Dilated-pupil acquisition. Acquired with a Topcon TRC-50DX.
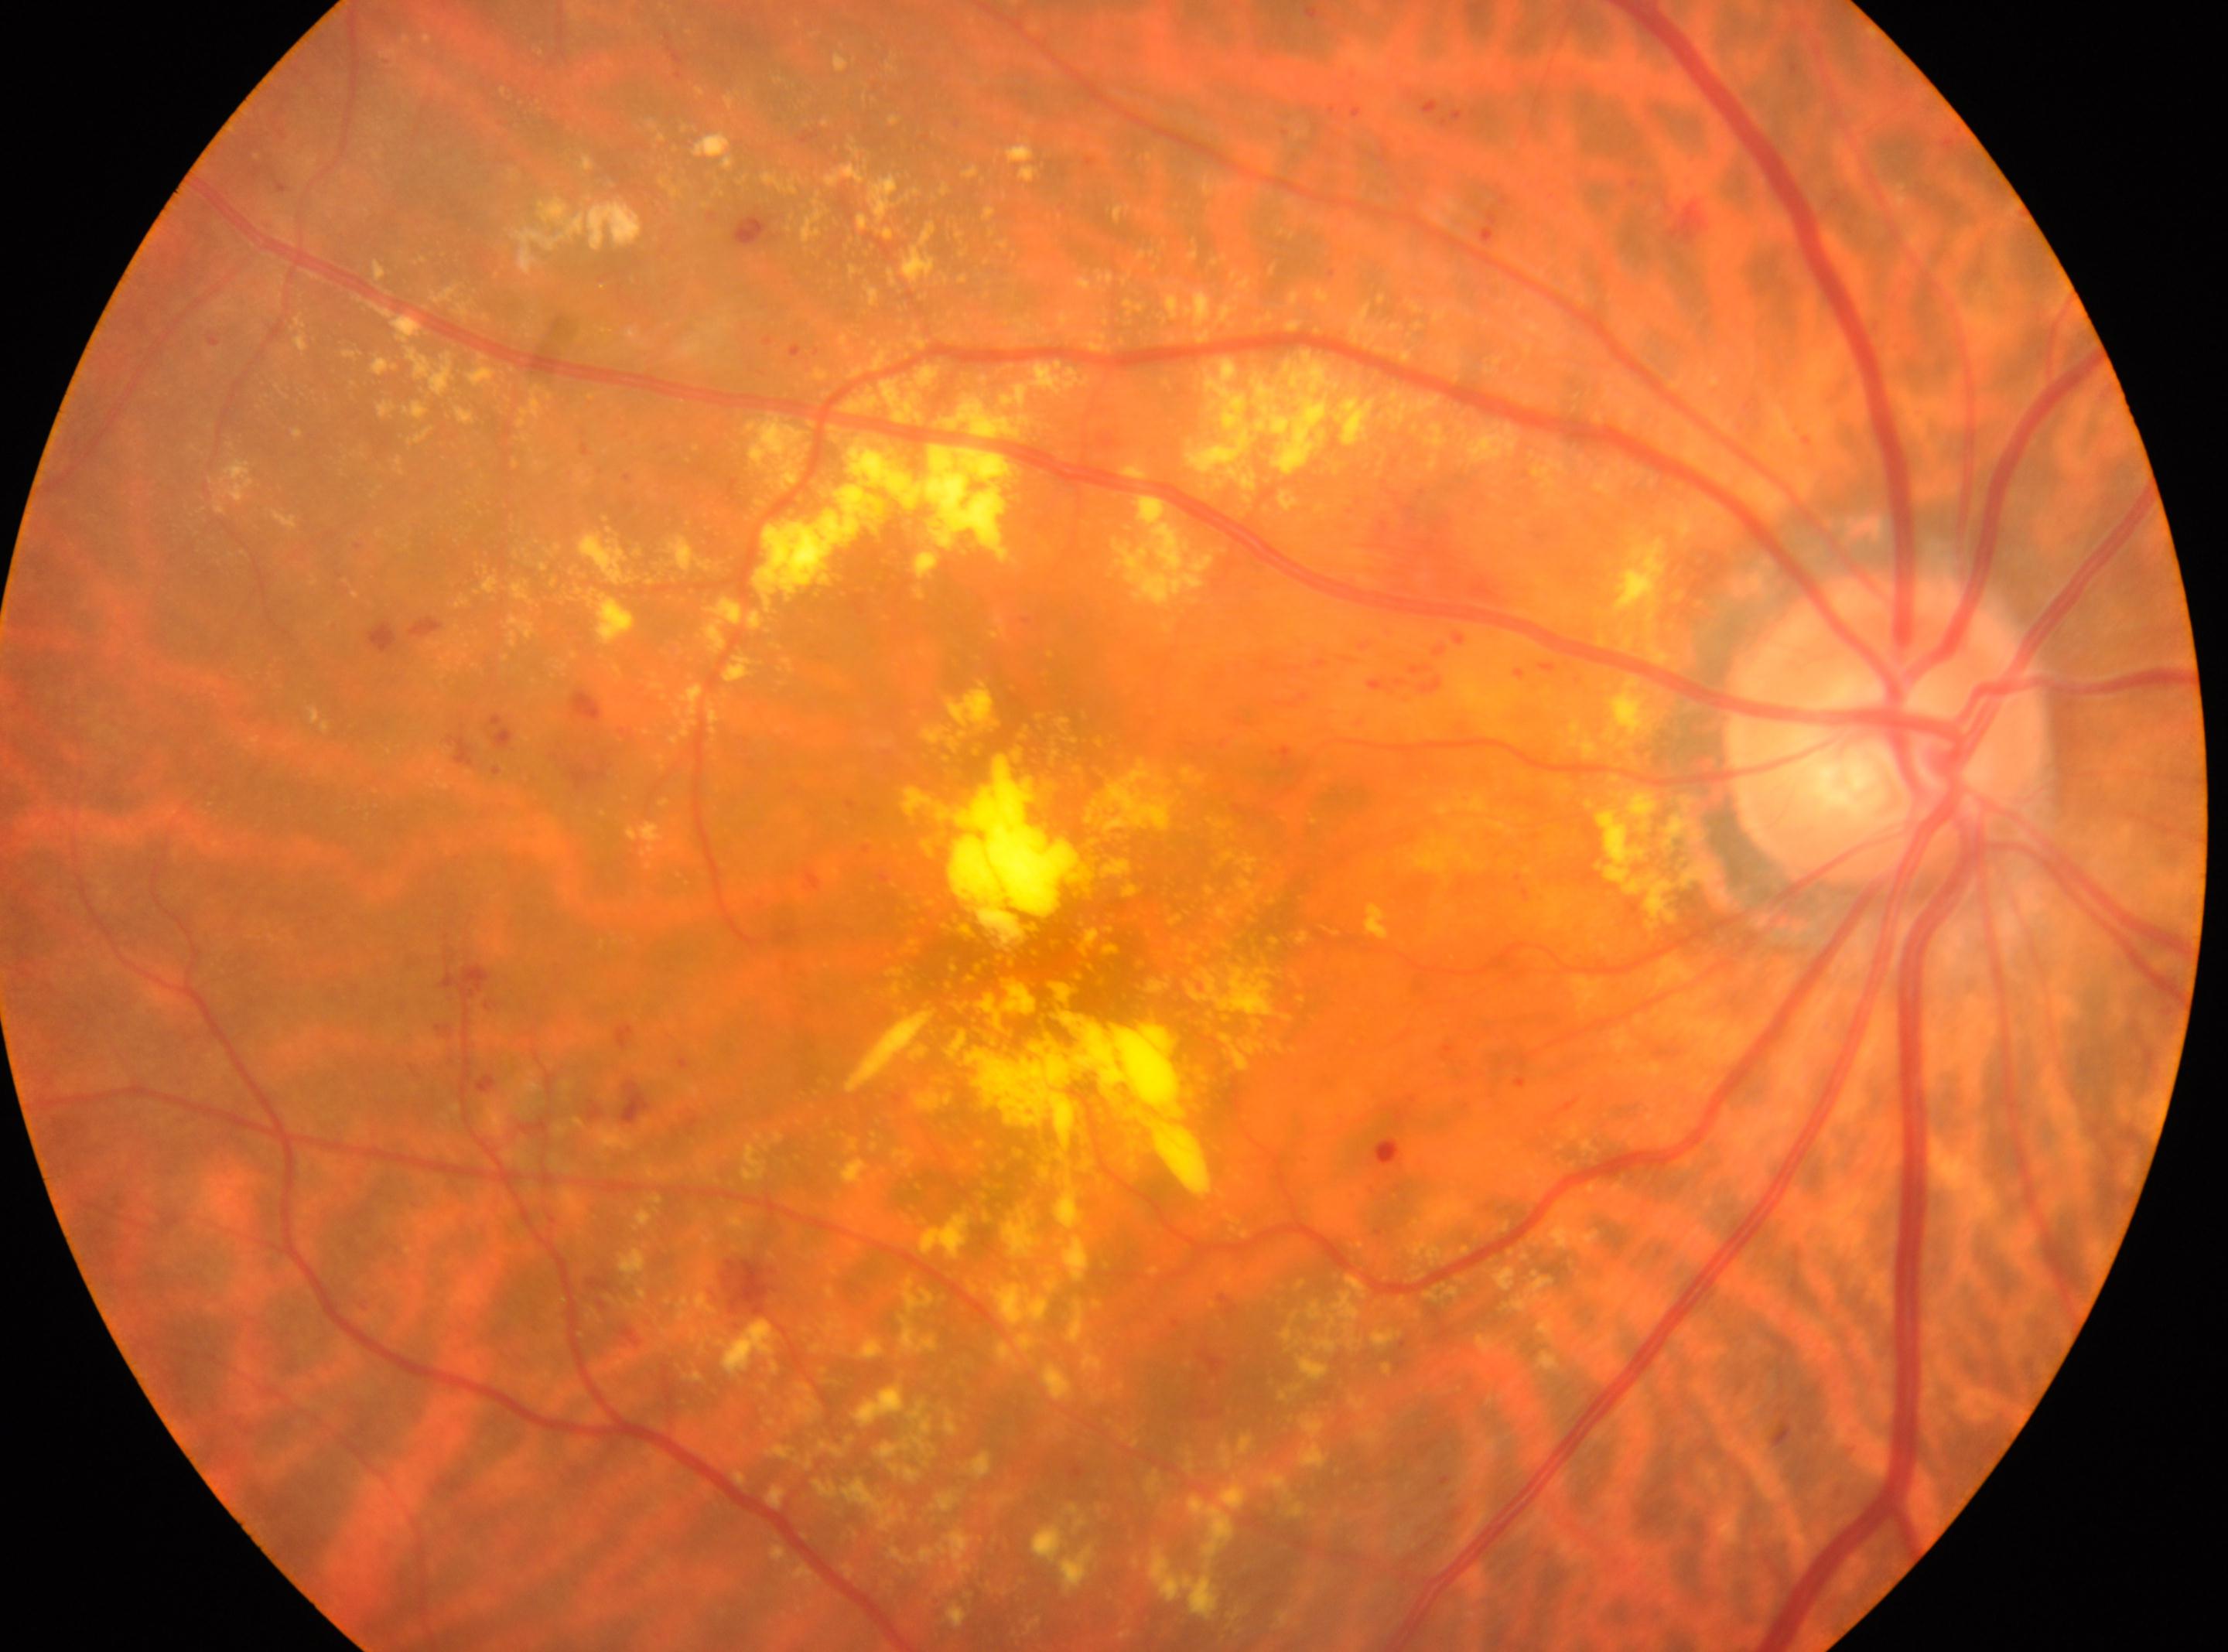

Macula center: (1054, 950). The image shows the right eye. Optic disc located at (1885, 725). Diabetic retinopathy grade is 2.